Fundus photo; 1659 by 2212 pixels; Remidio smartphone fundus camera.
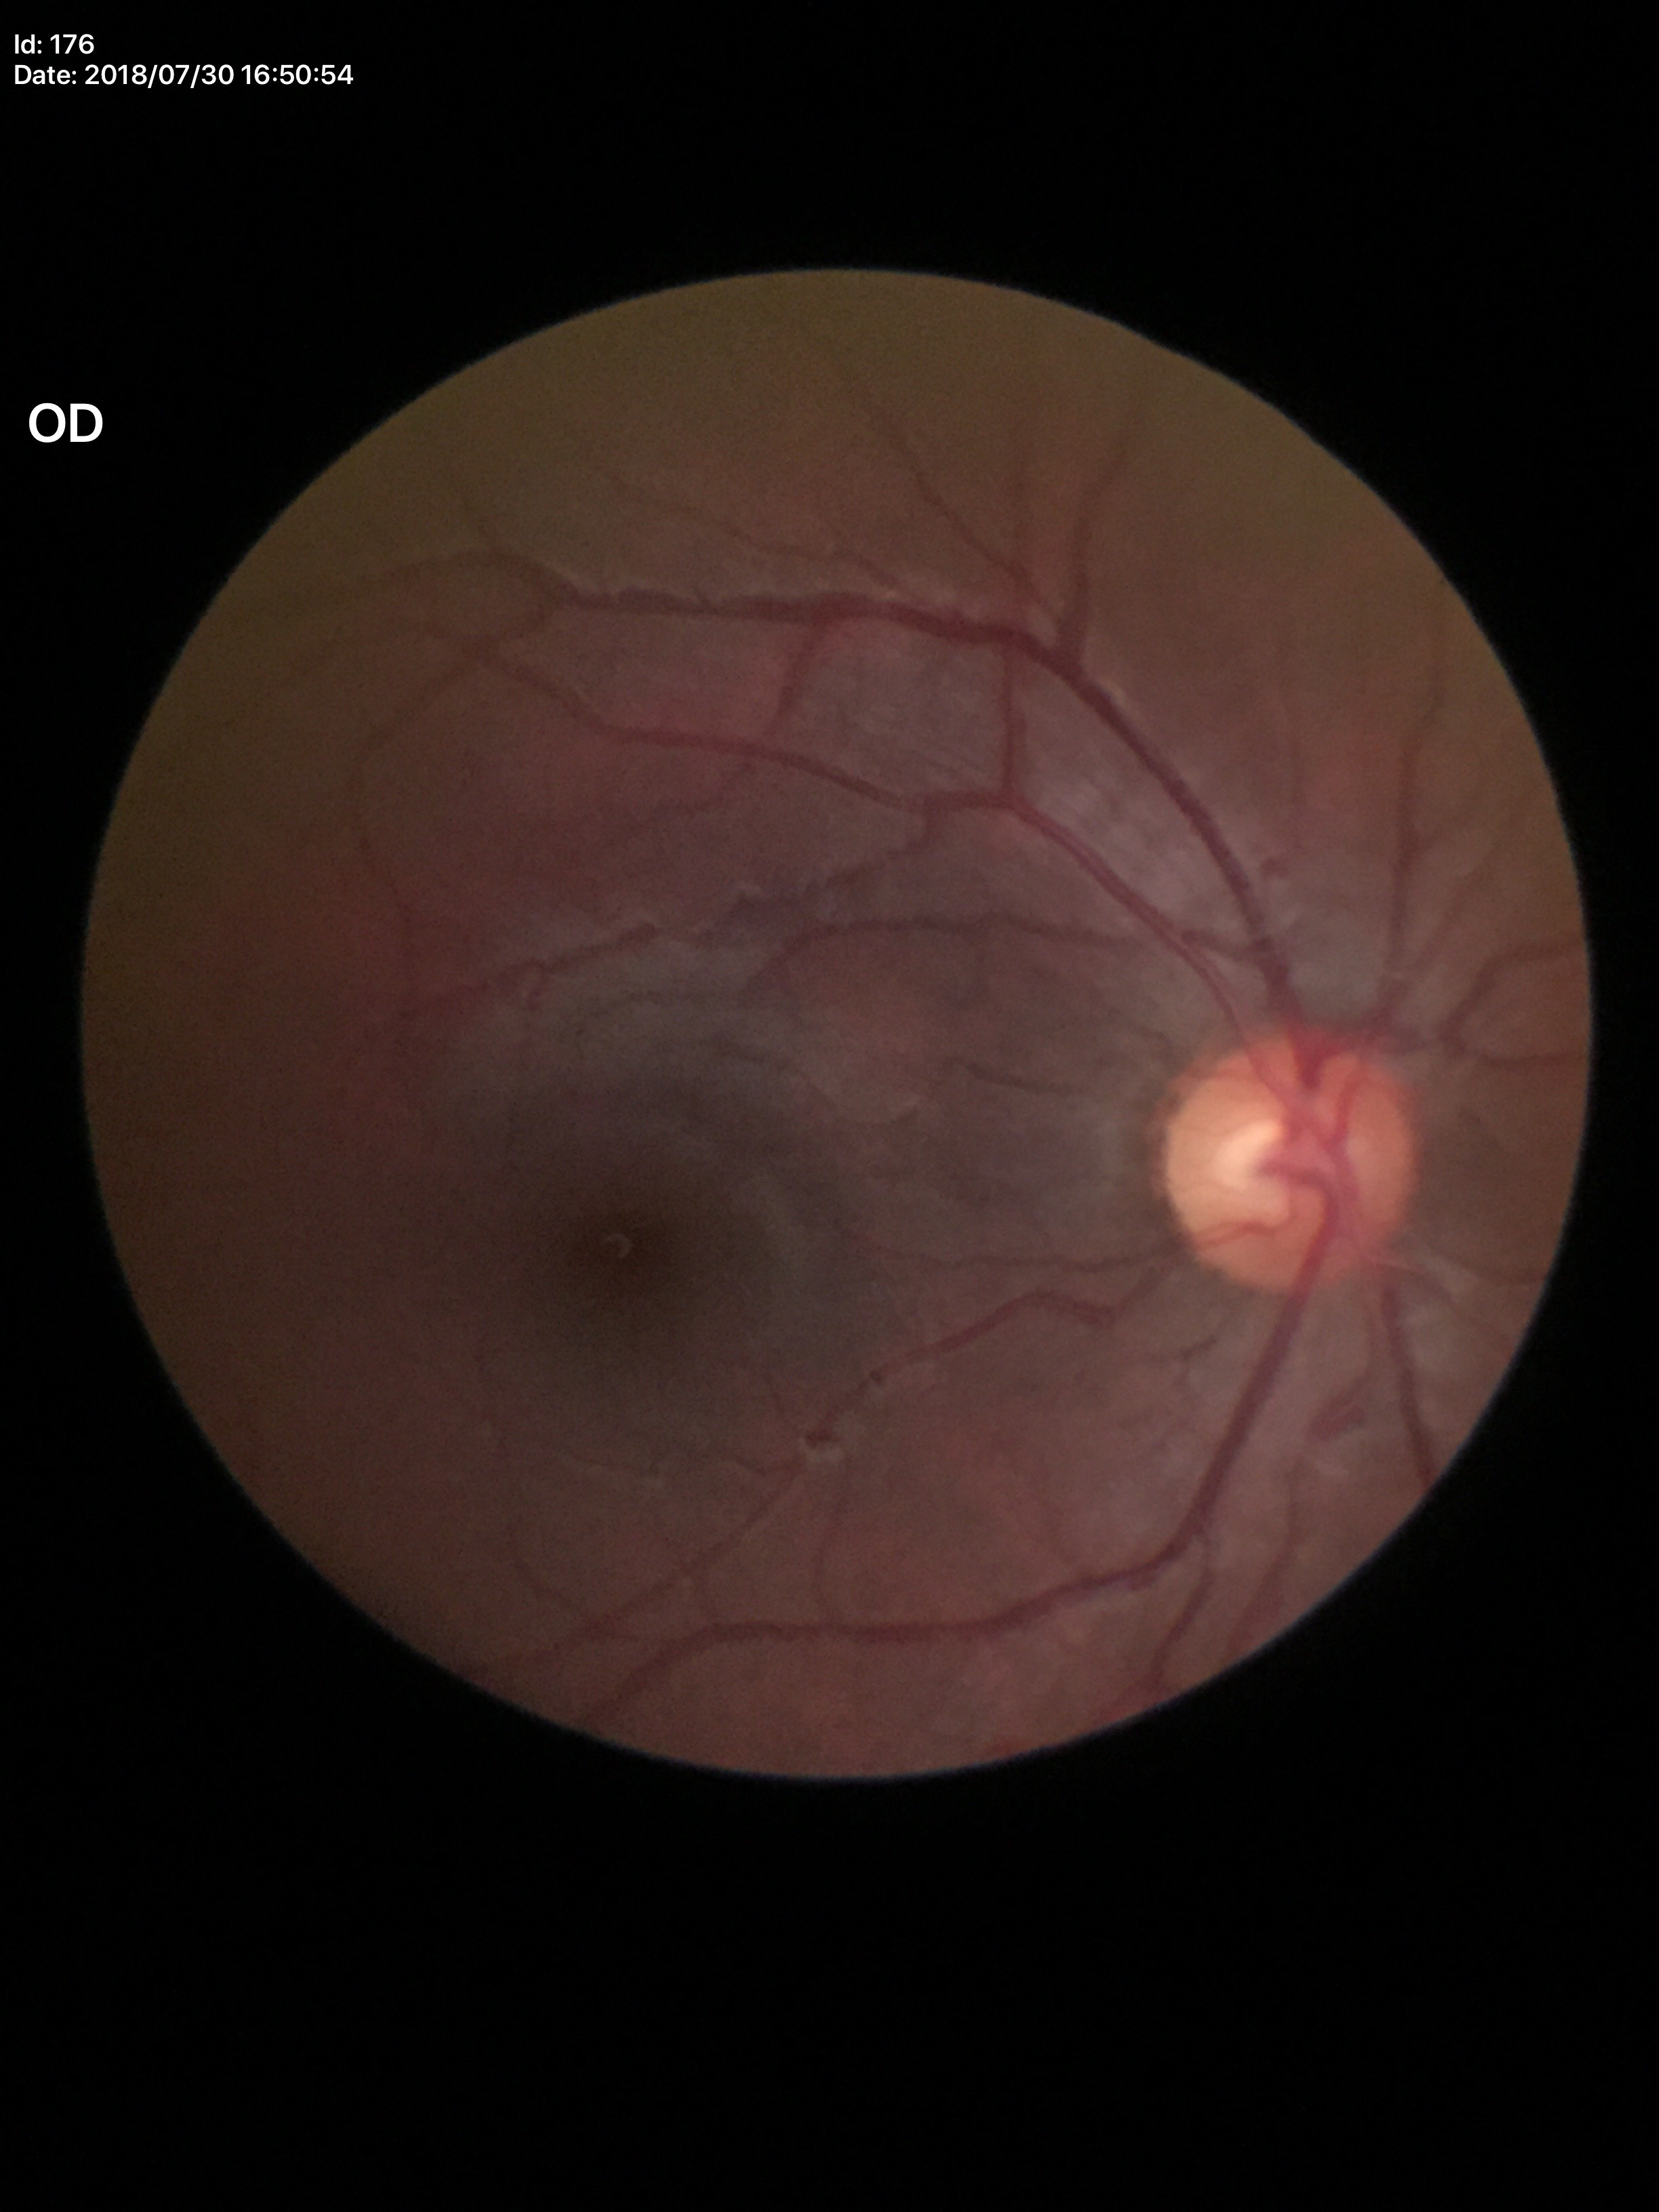

Glaucoma impression: no suspicious findings. Vertical cup-disc ratio (VCDR) is 0.51.